Color fundus photograph; 1659 x 2212 pixels — 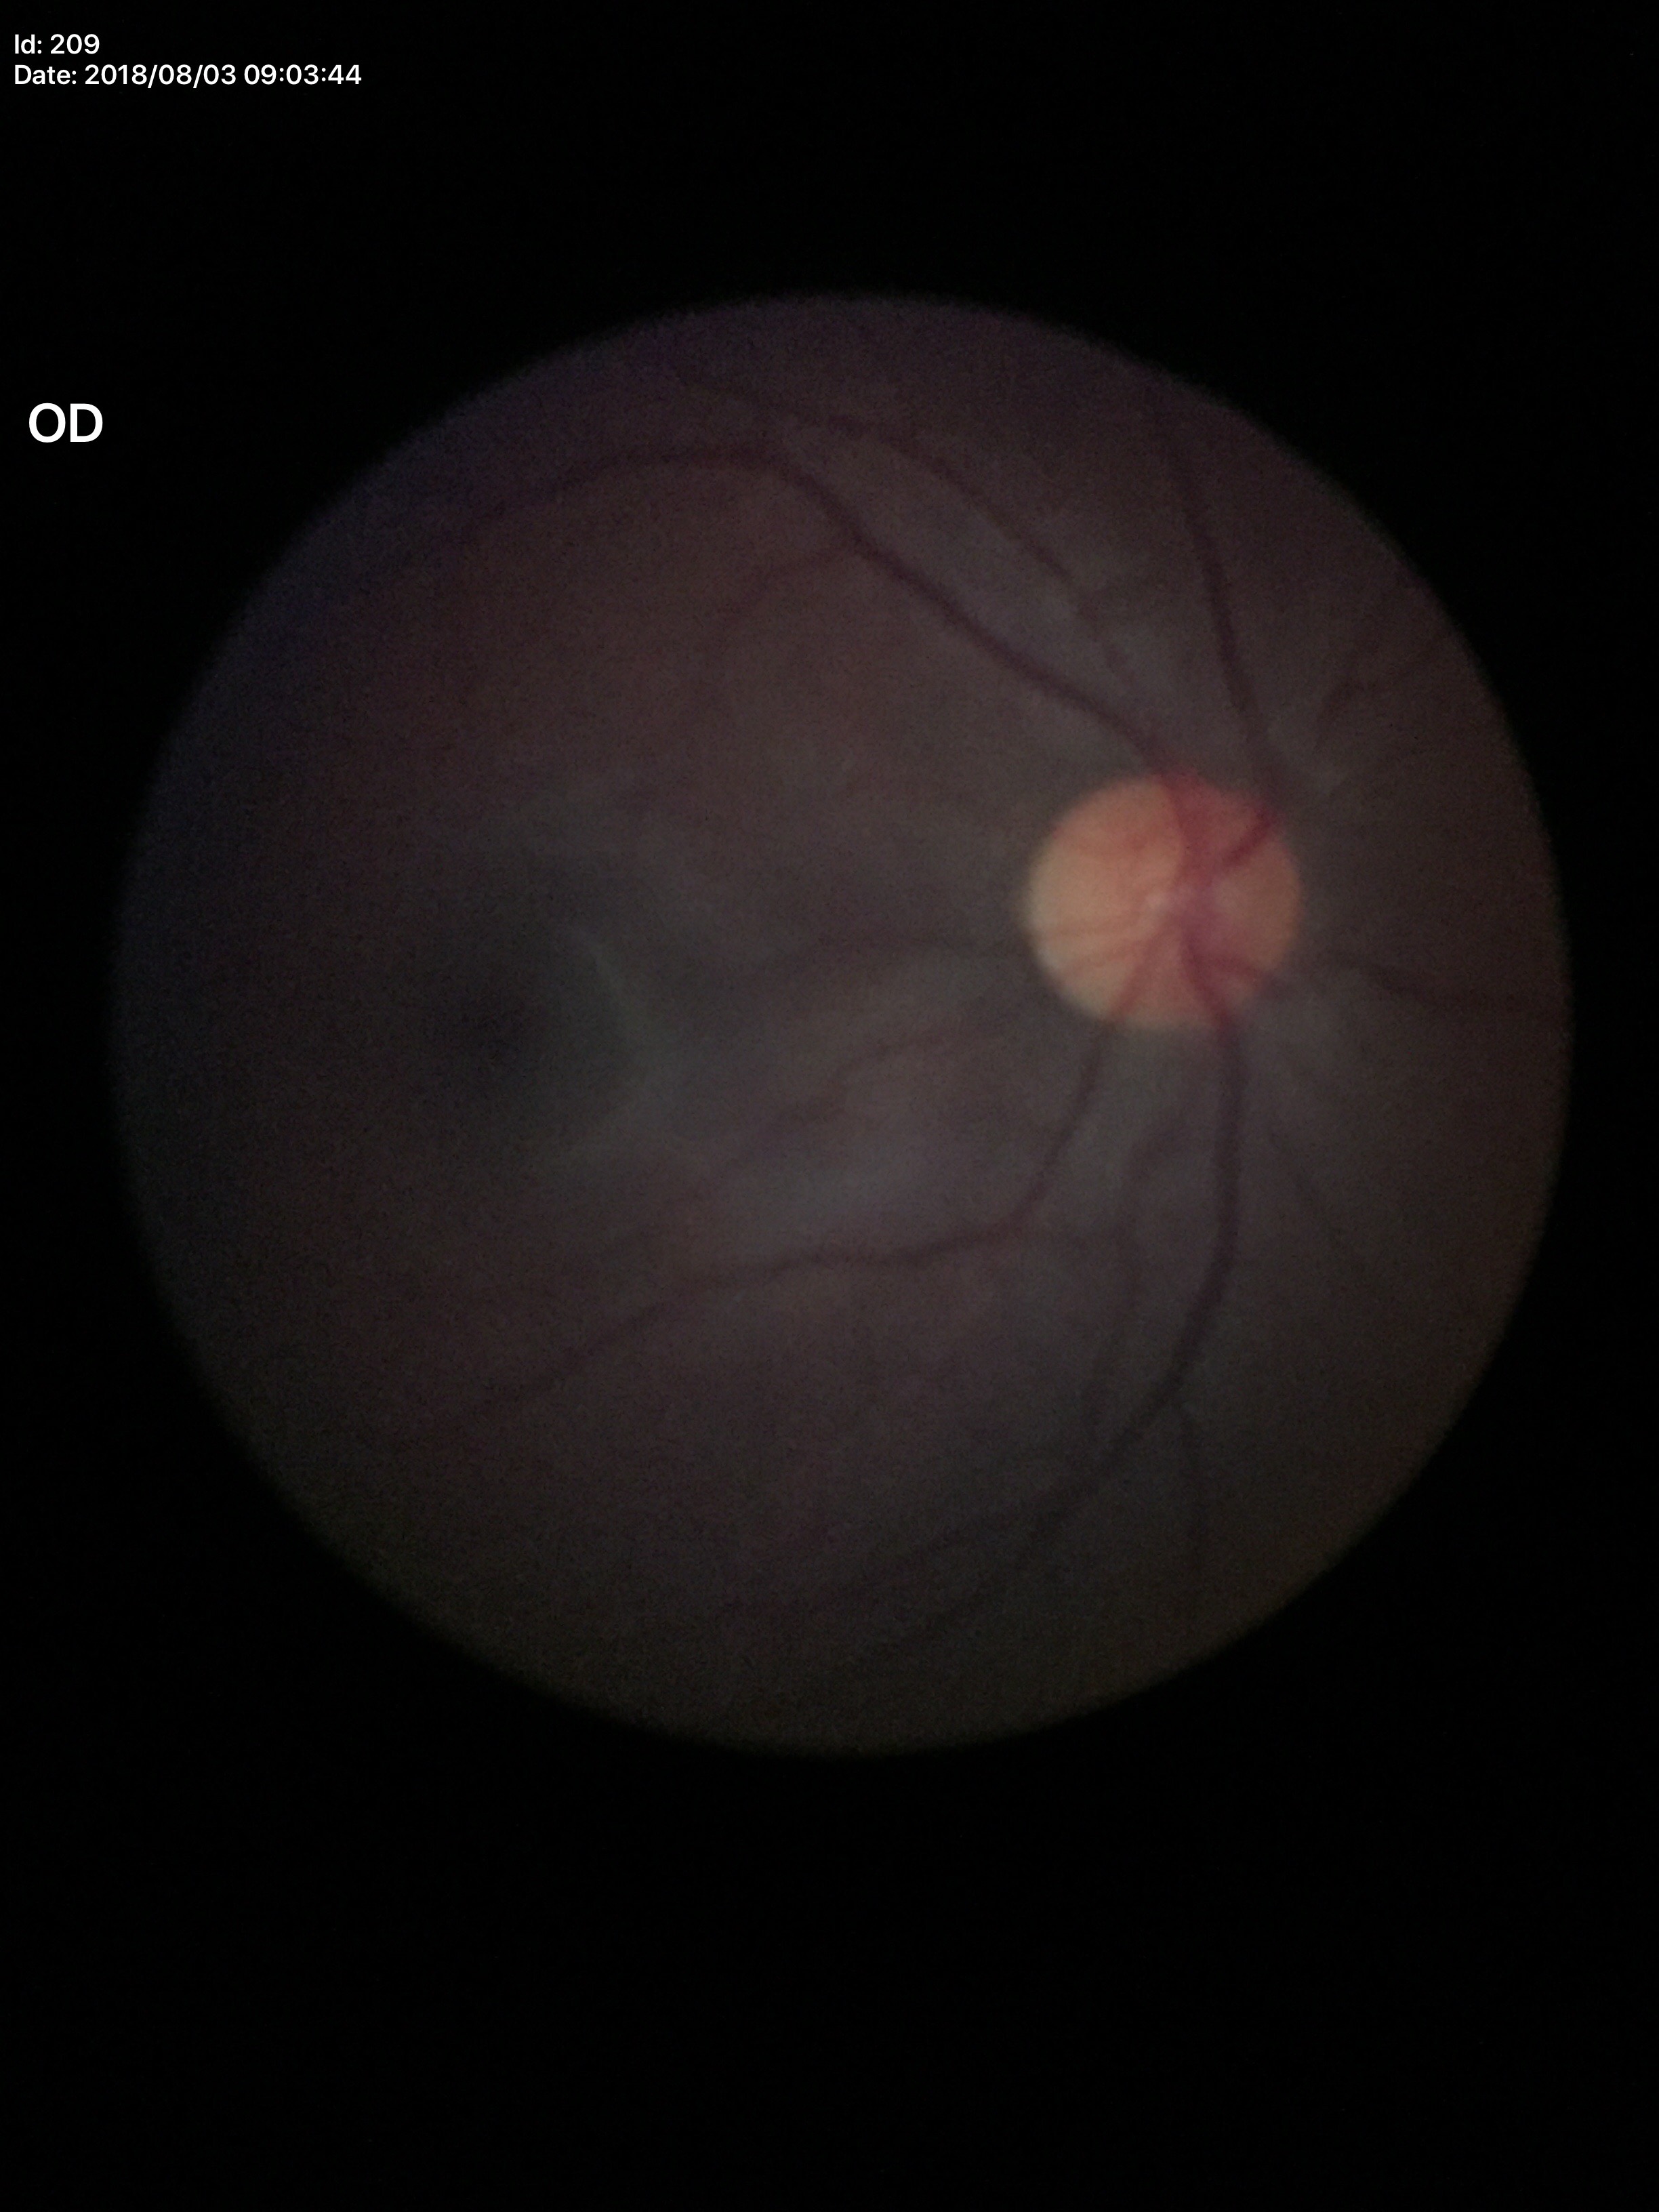 Optic disc analysis:
* Glaucoma evaluation: no suspicious findings
* vertical cup-disc ratio: 0.32